Modified Davis classification · nonmydriatic
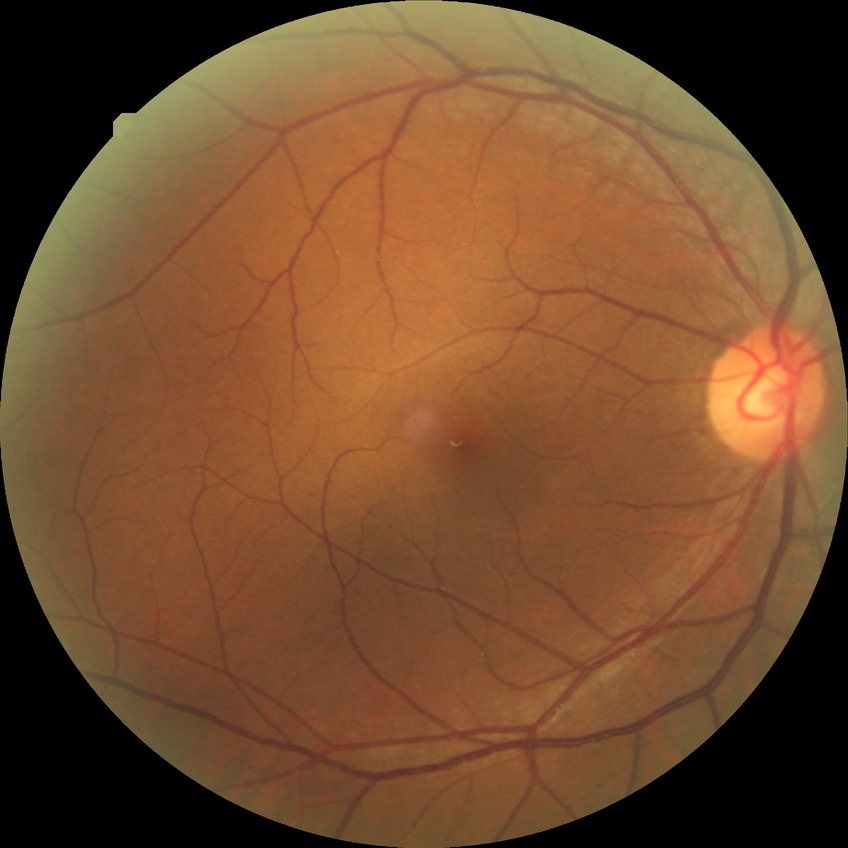

Modified Davis classification is no diabetic retinopathy.